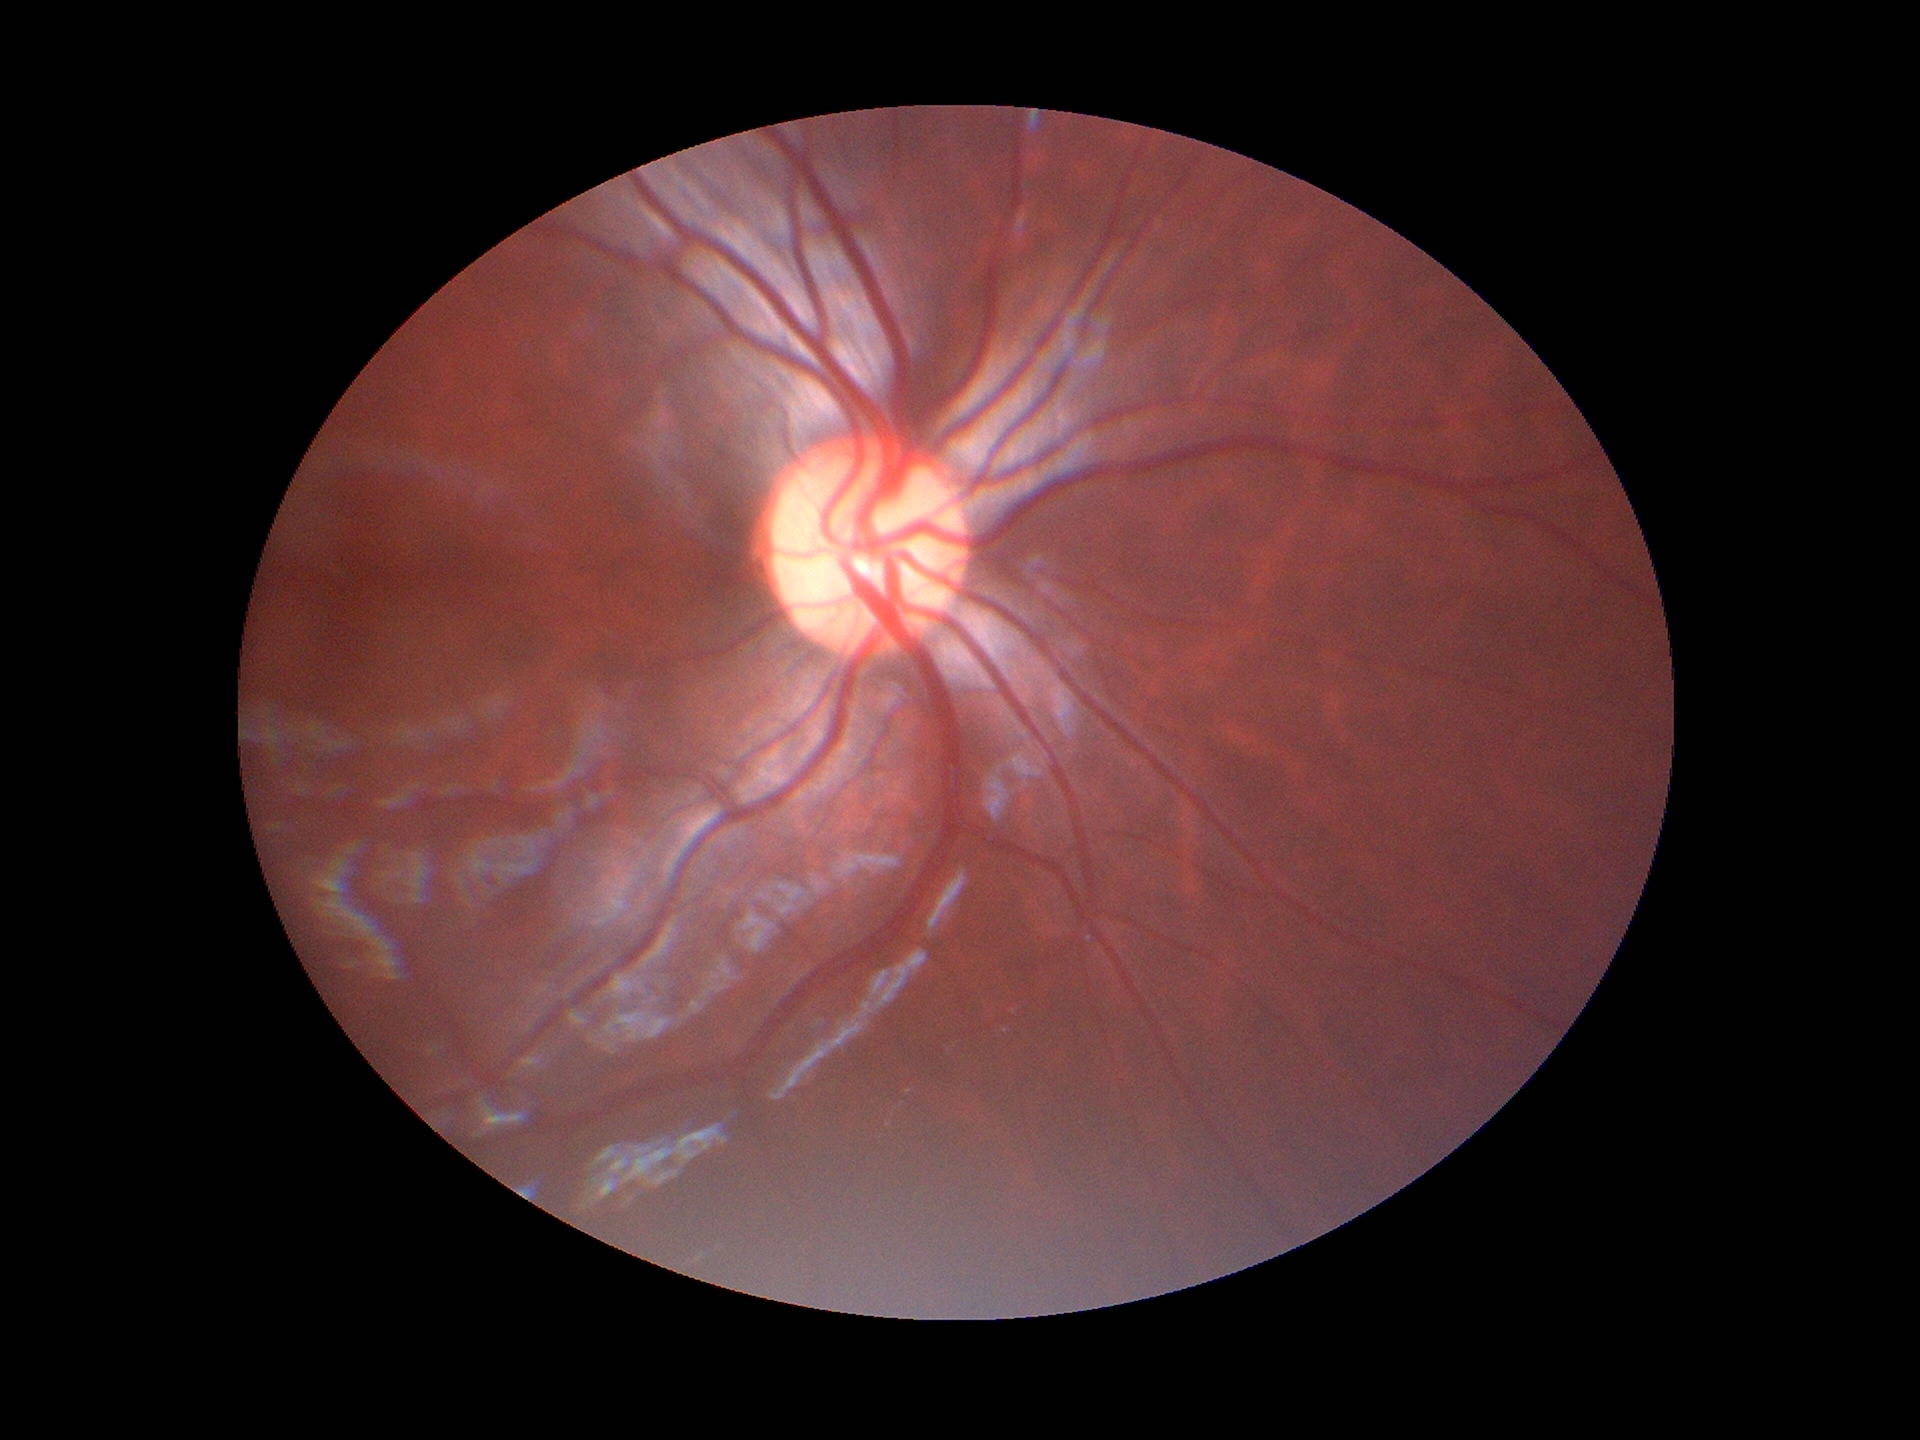 VCDR: 0.52. Glaucoma screening impression: negative.